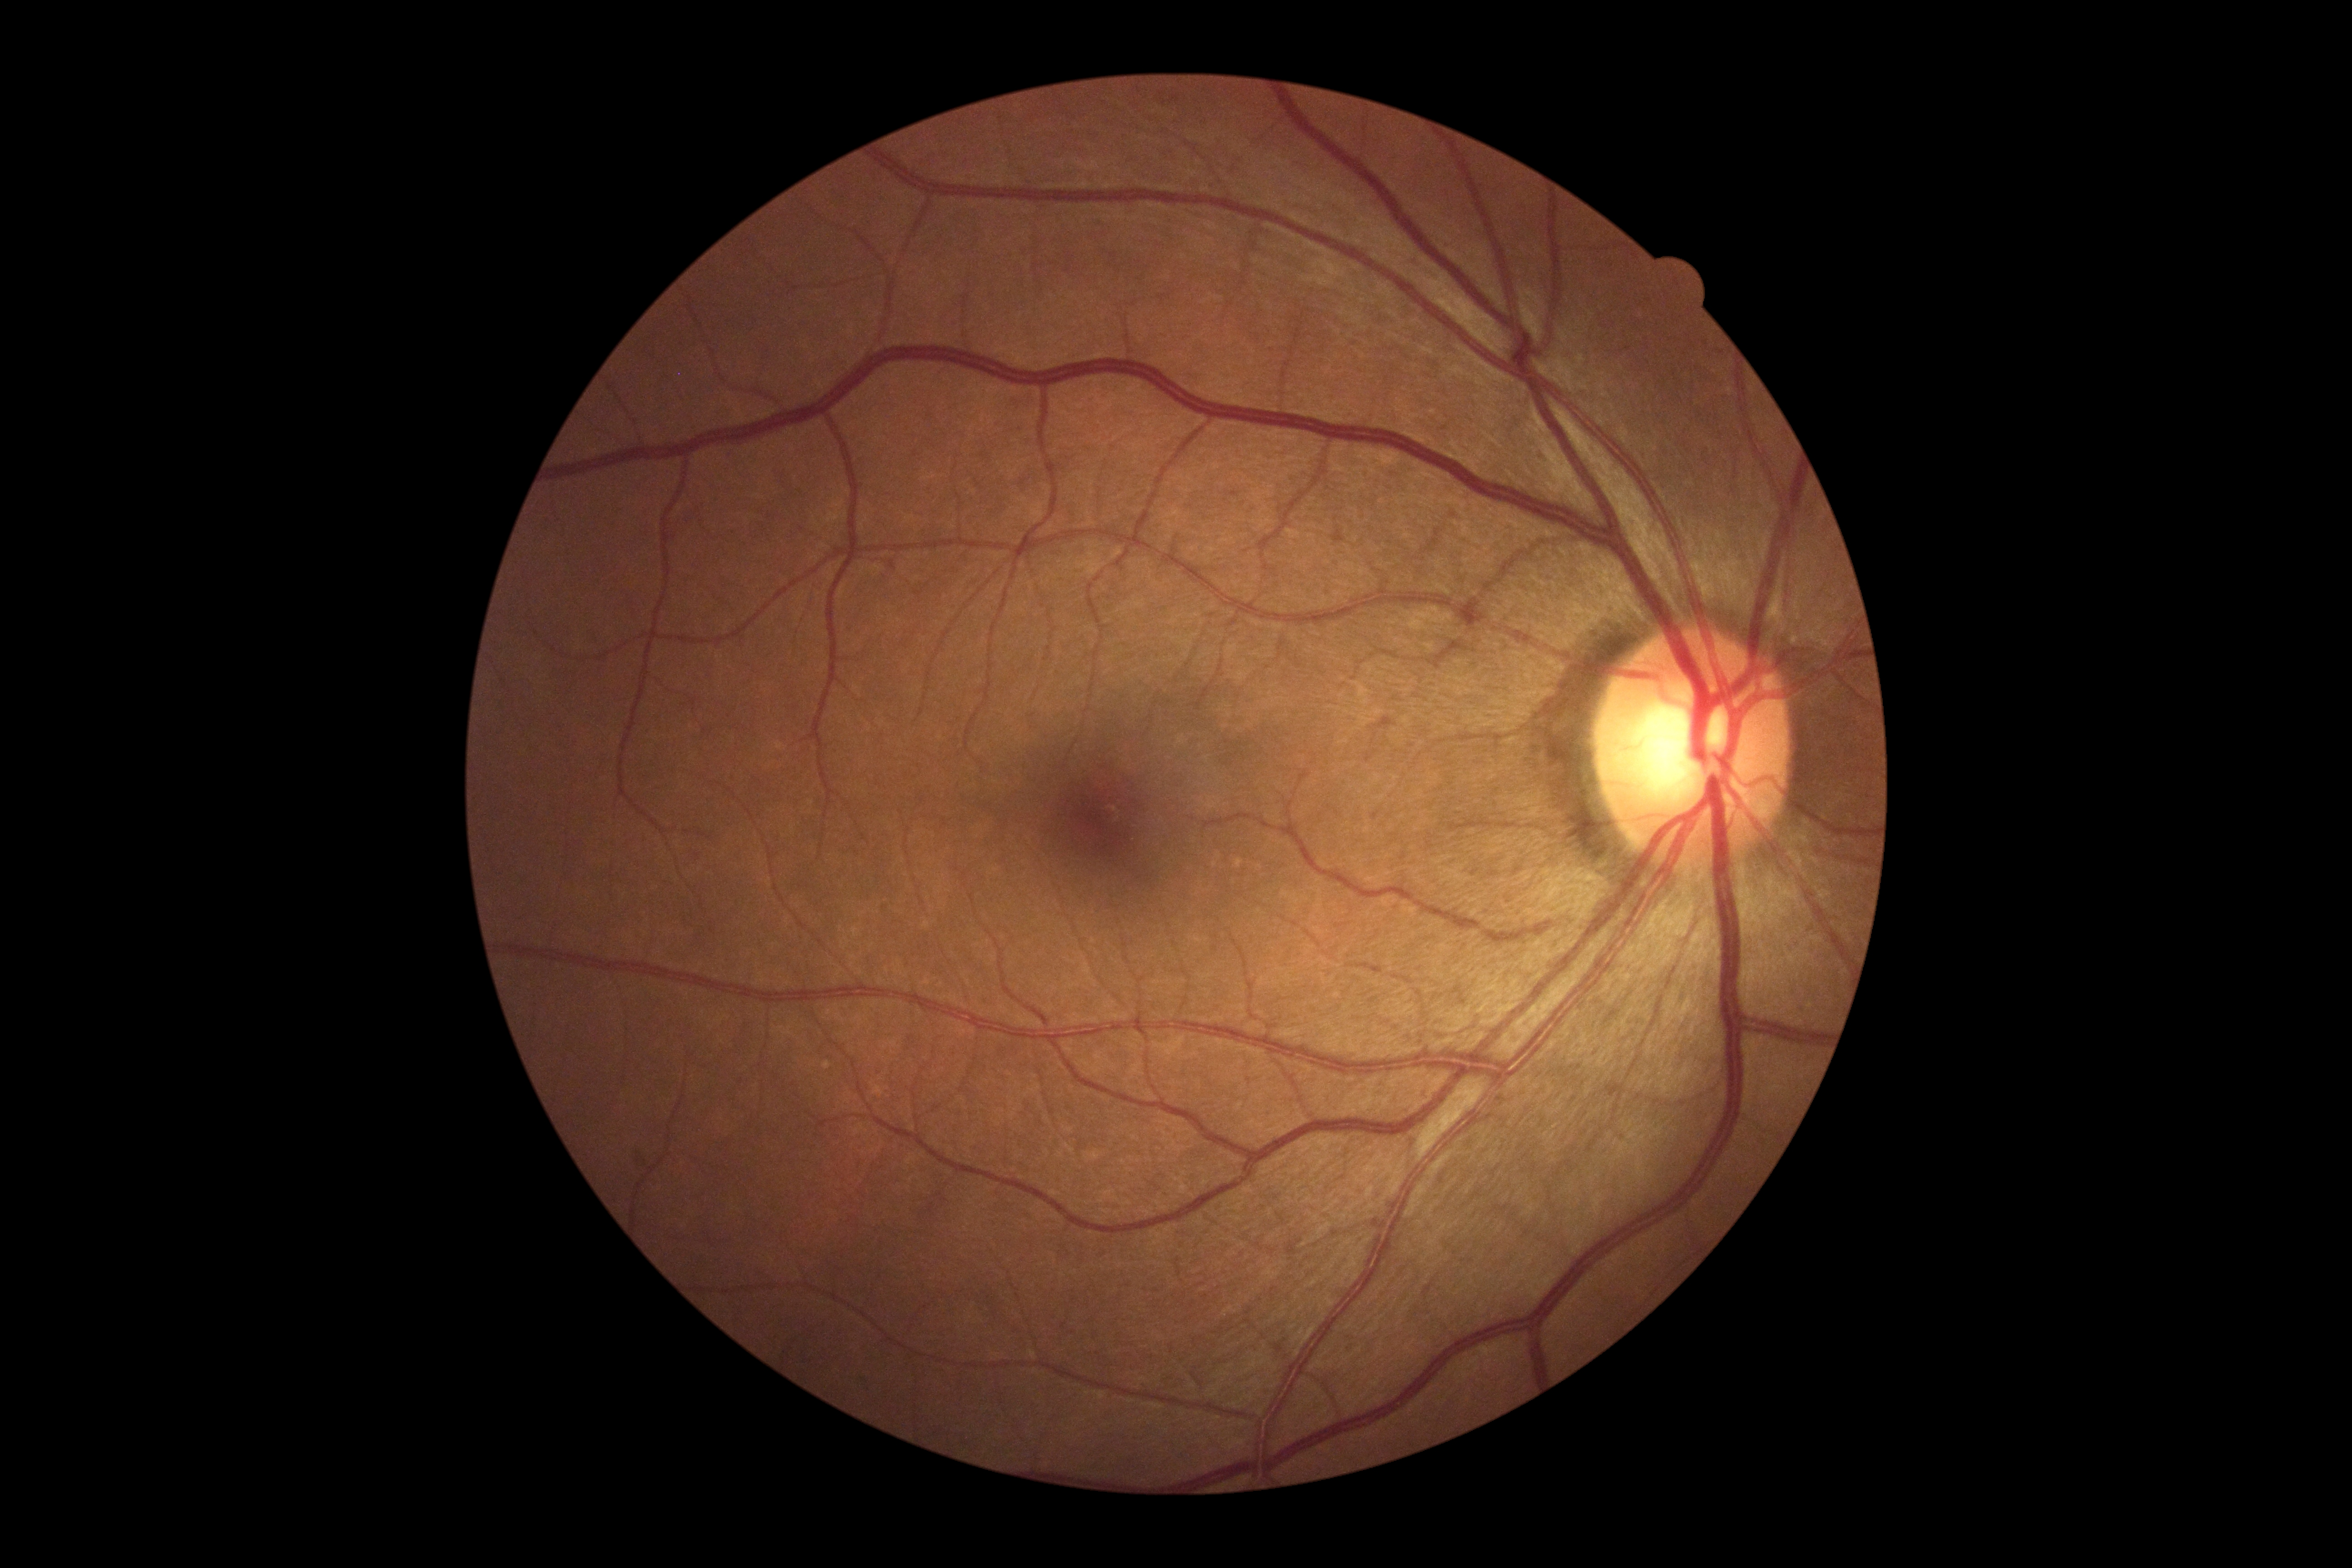

DR grade = 0 — no visible signs of diabetic retinopathy.